45° field of view. 2212 by 1659 pixels.
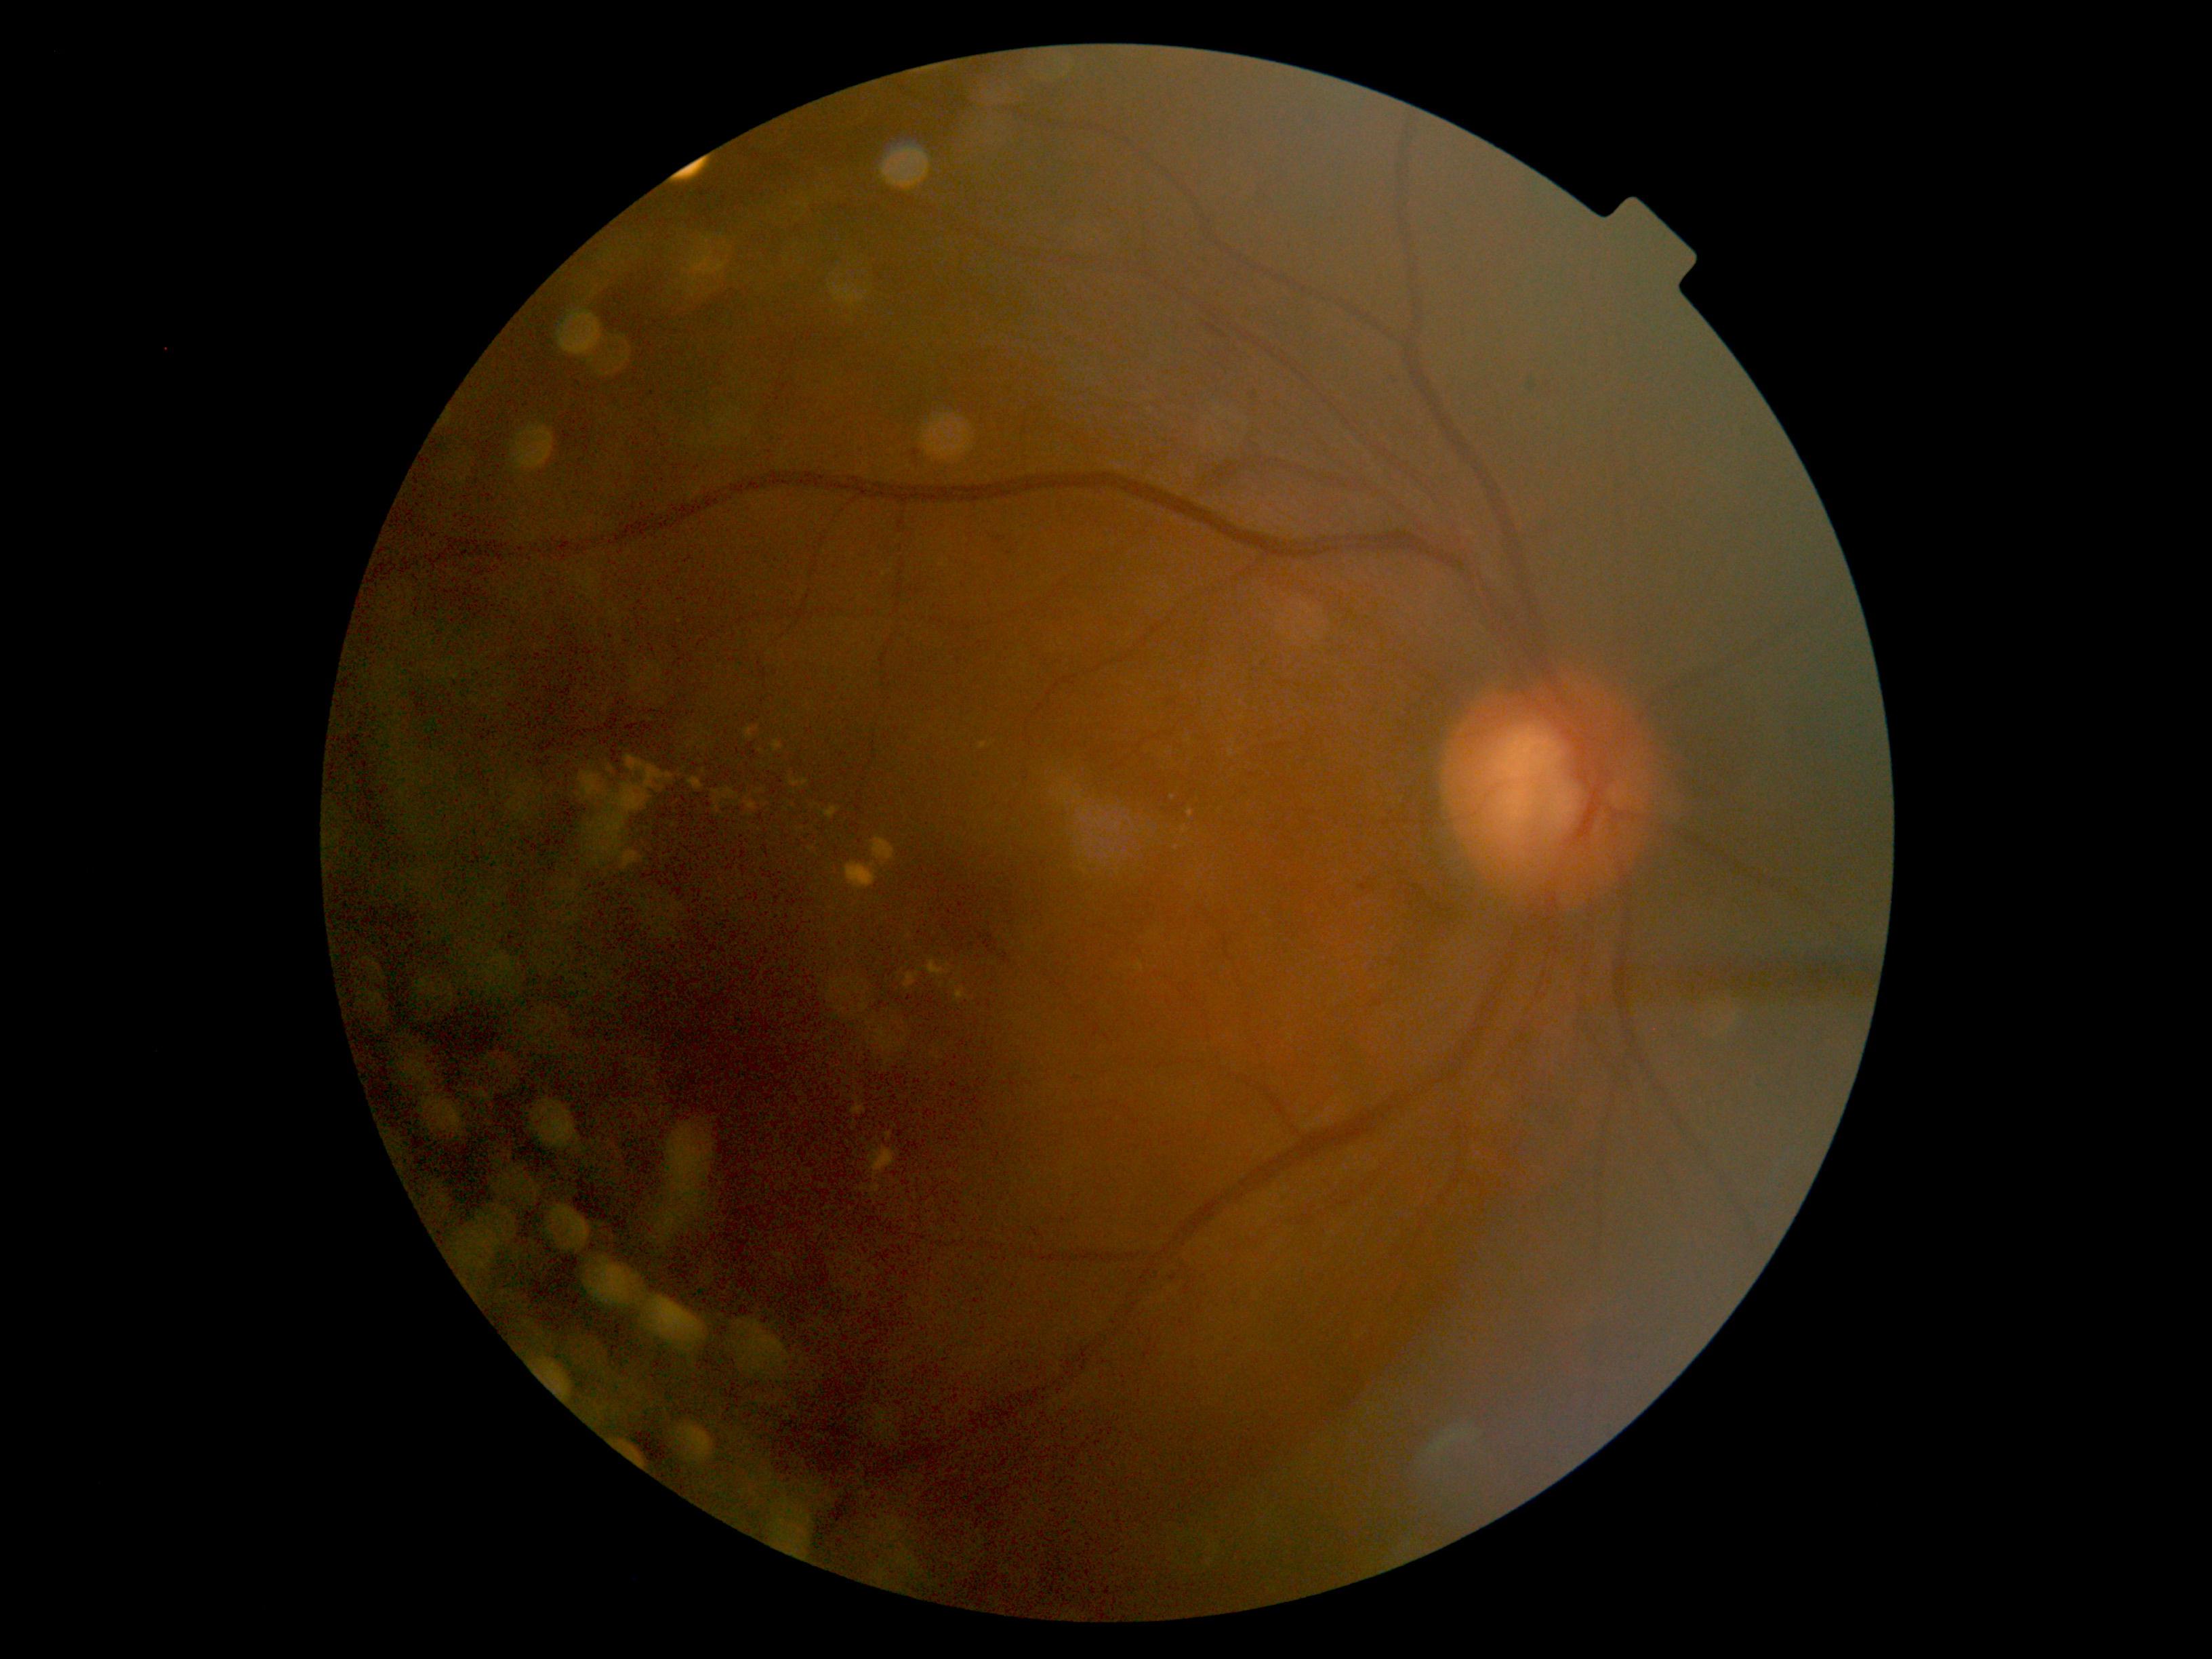 diabetic retinopathy (DR): 2/4.